50° FOV · fundus photo · image size 2228x1652 · camera: Topcon TRC-50DX.
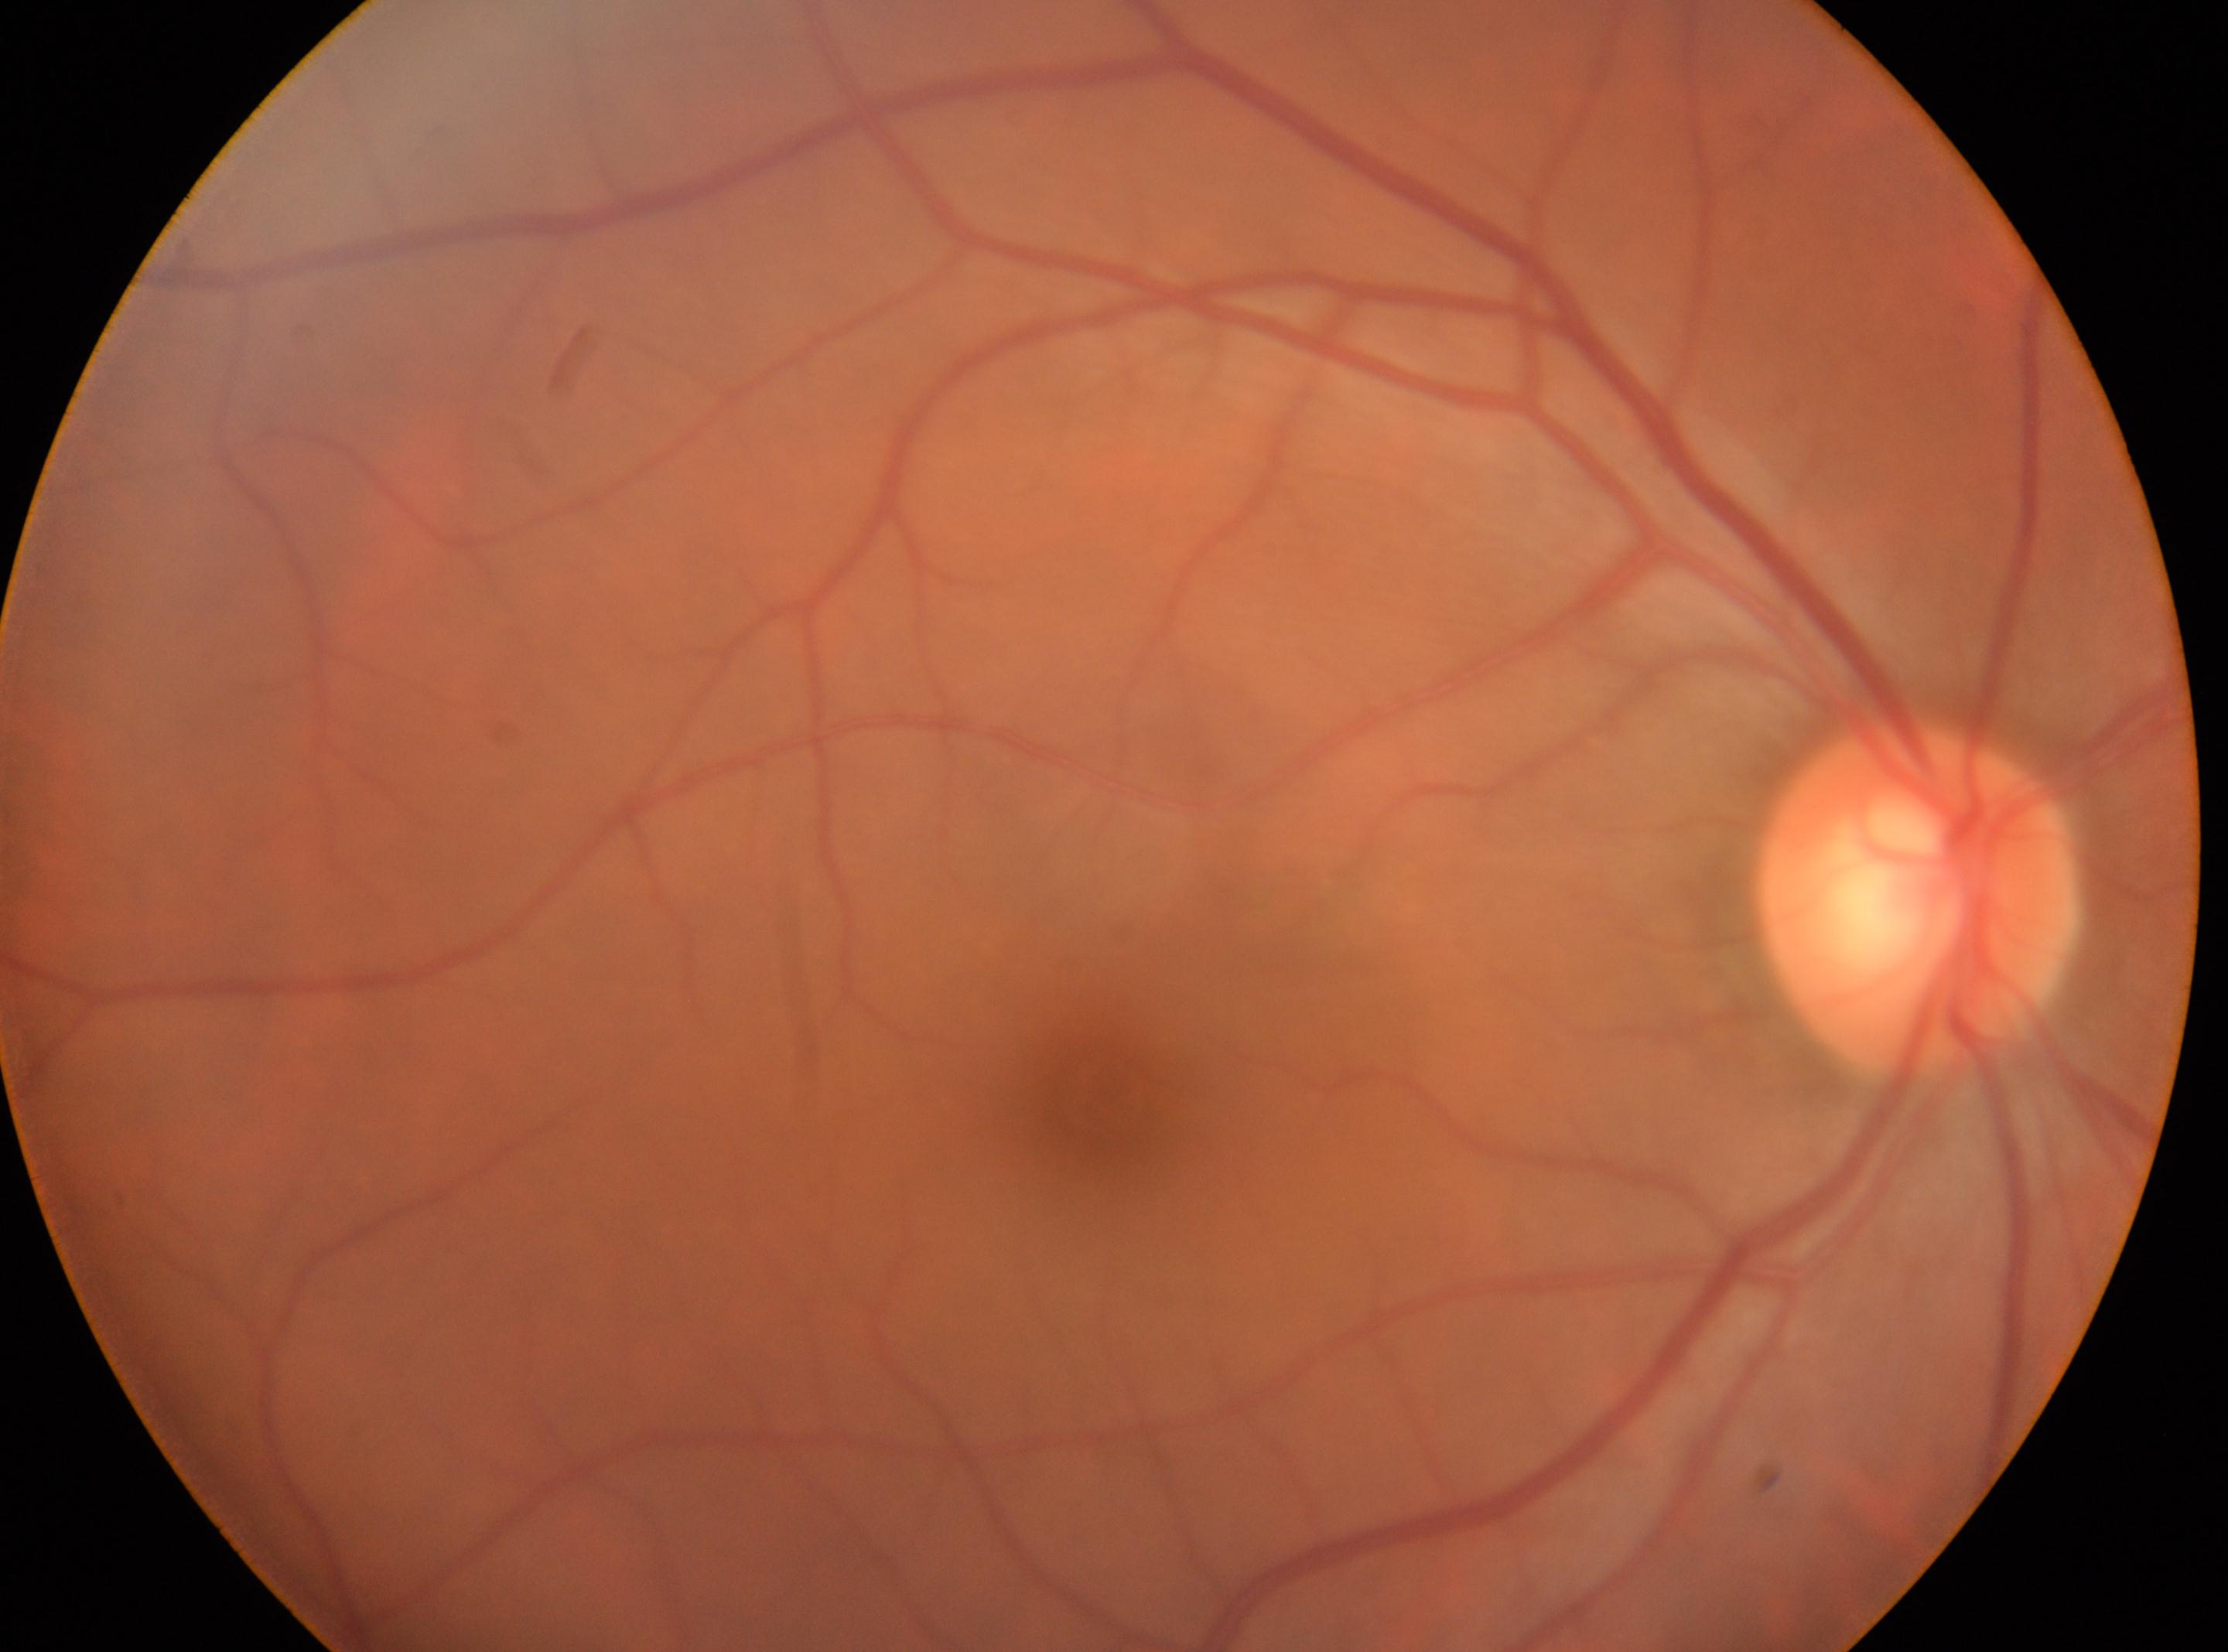

Eye: the right eye. DR severity: 0/4. Fovea center located at (1100, 1100). Optic disc center: (1917, 900).